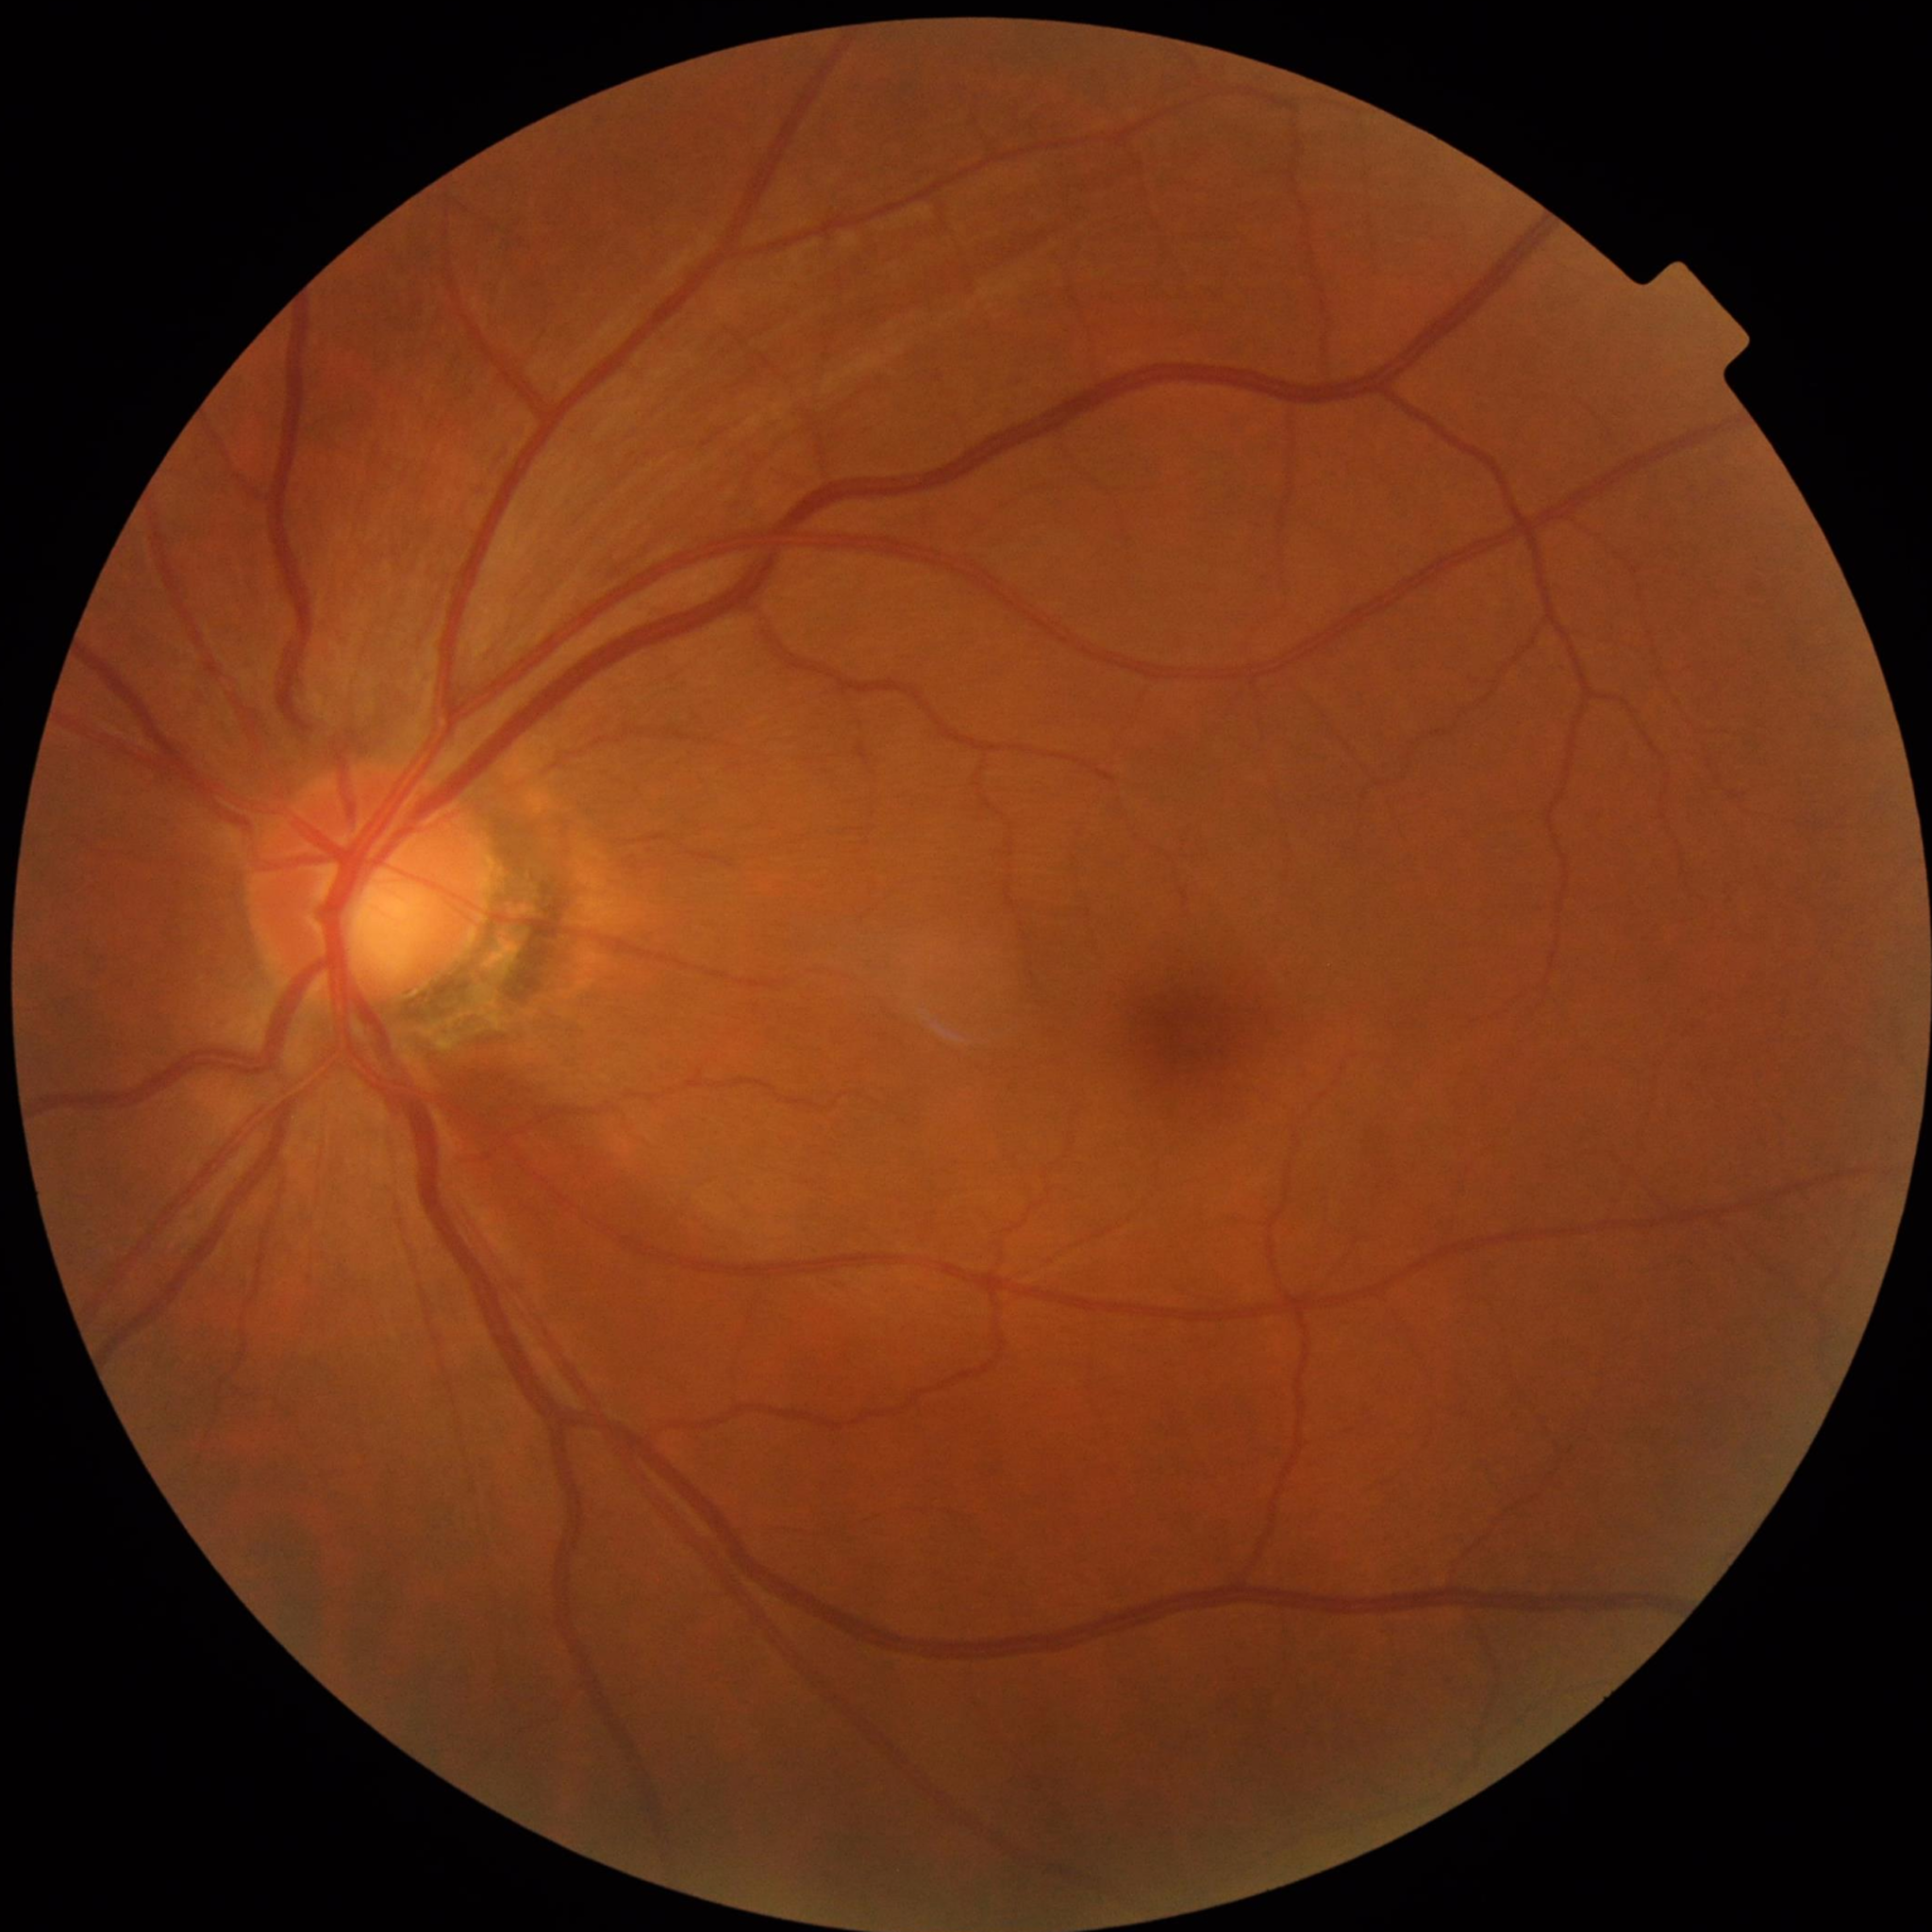
Impression: no AMD, DR, or glaucomatous findings.